Tabletop color fundus camera image — 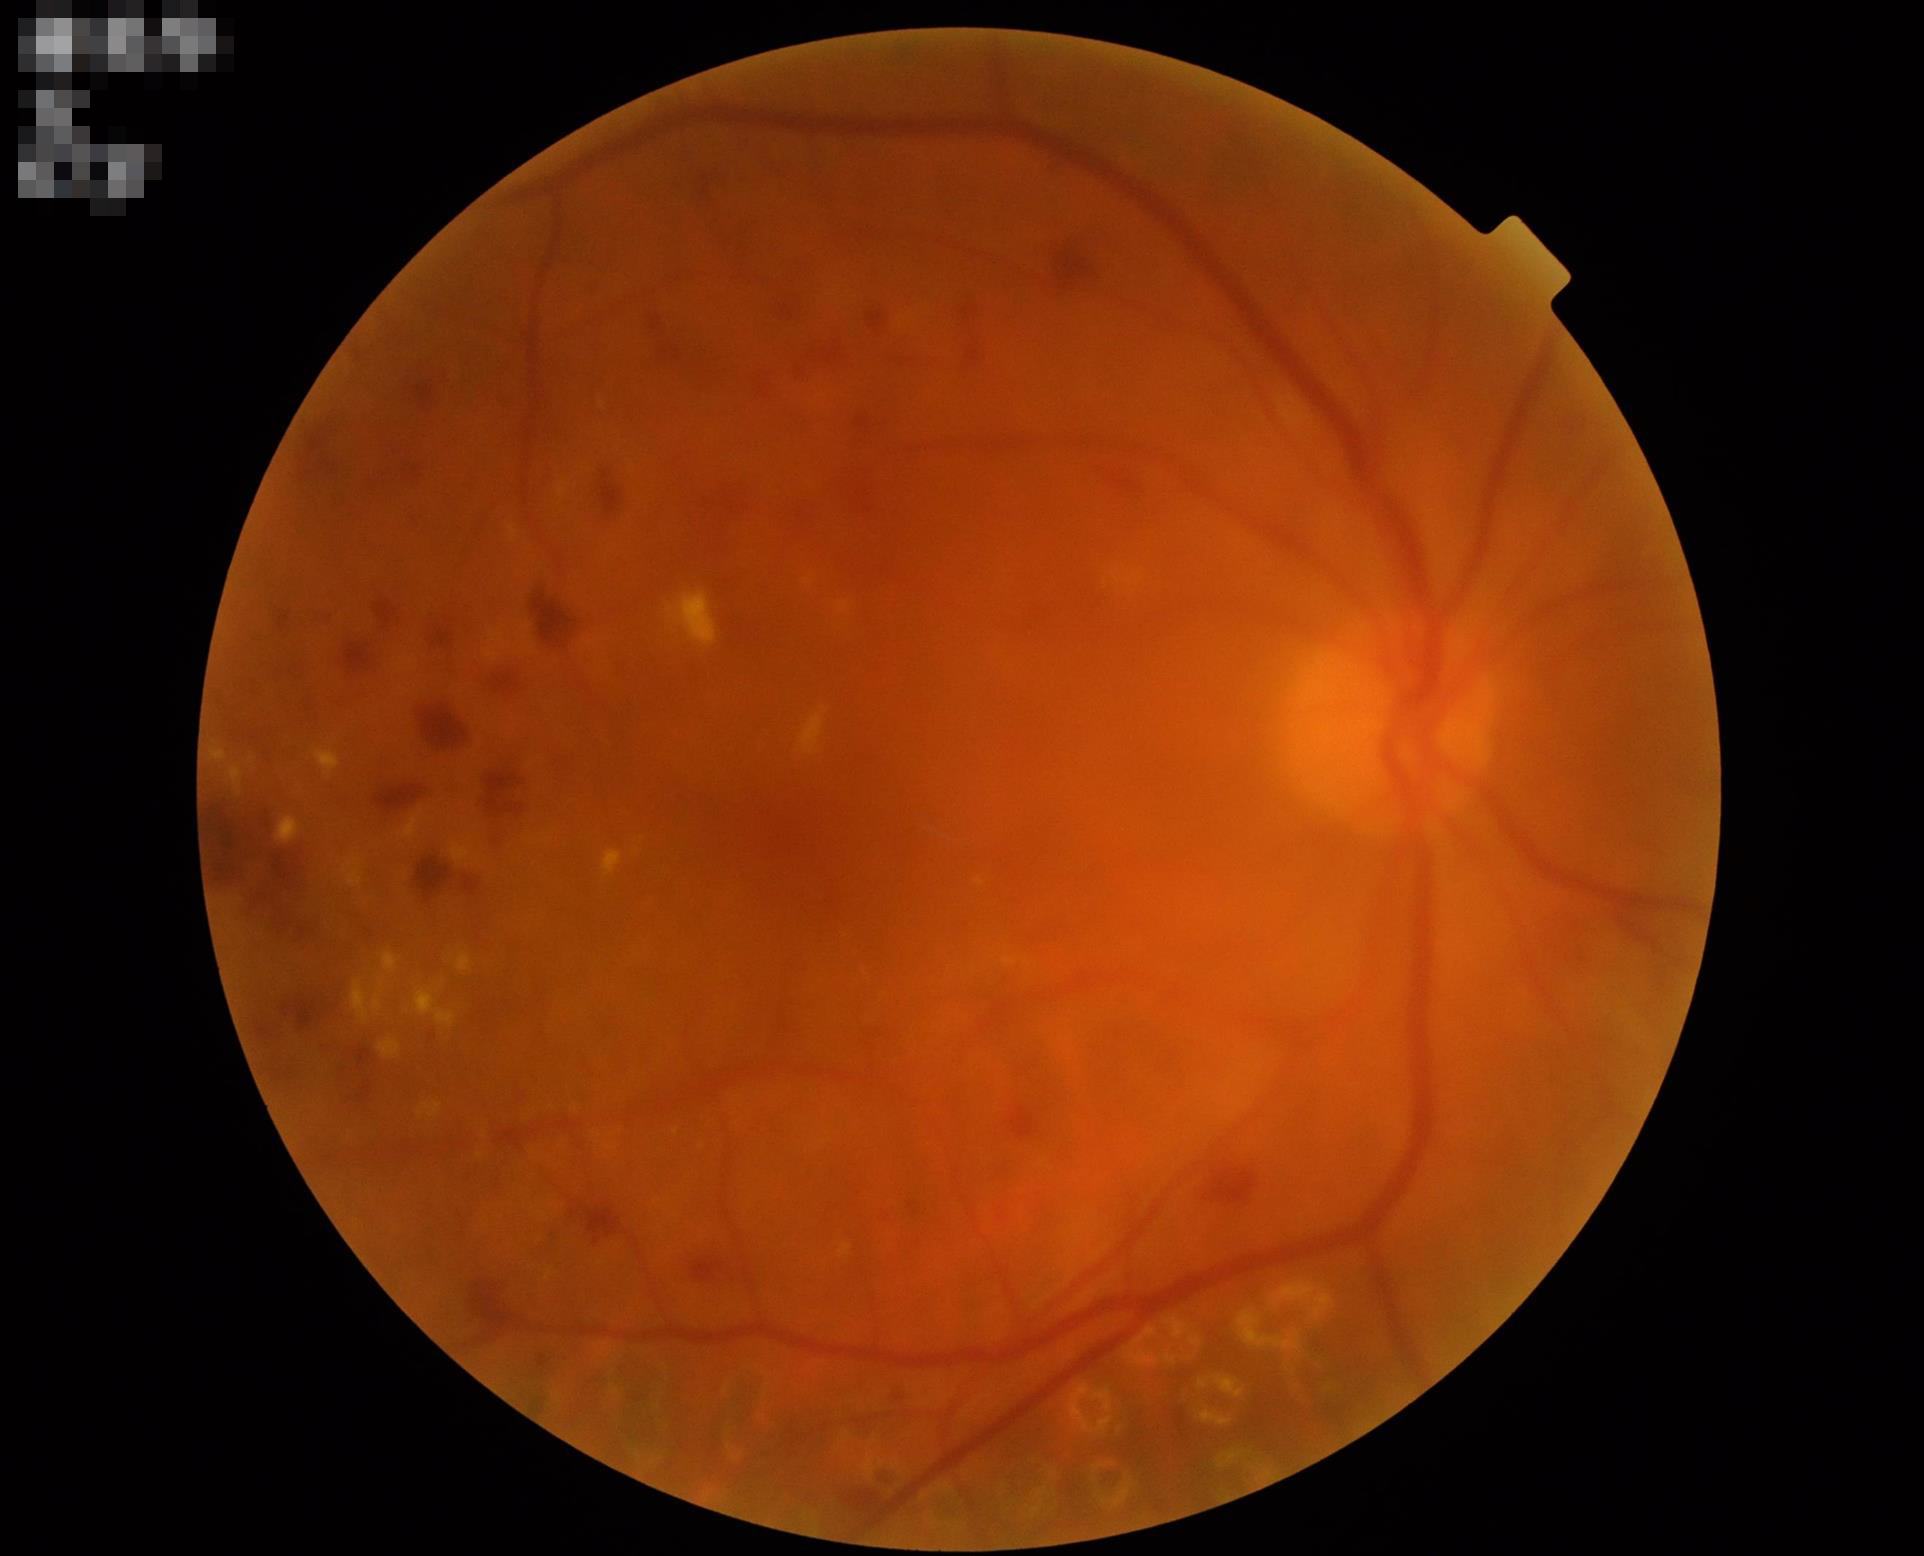

Out of focus; structures are indistinct.
Image quality is inadequate for diagnostic use.
Contrast is good.